Retinal fundus photograph; 2352x1568; FOV: 45 degrees:
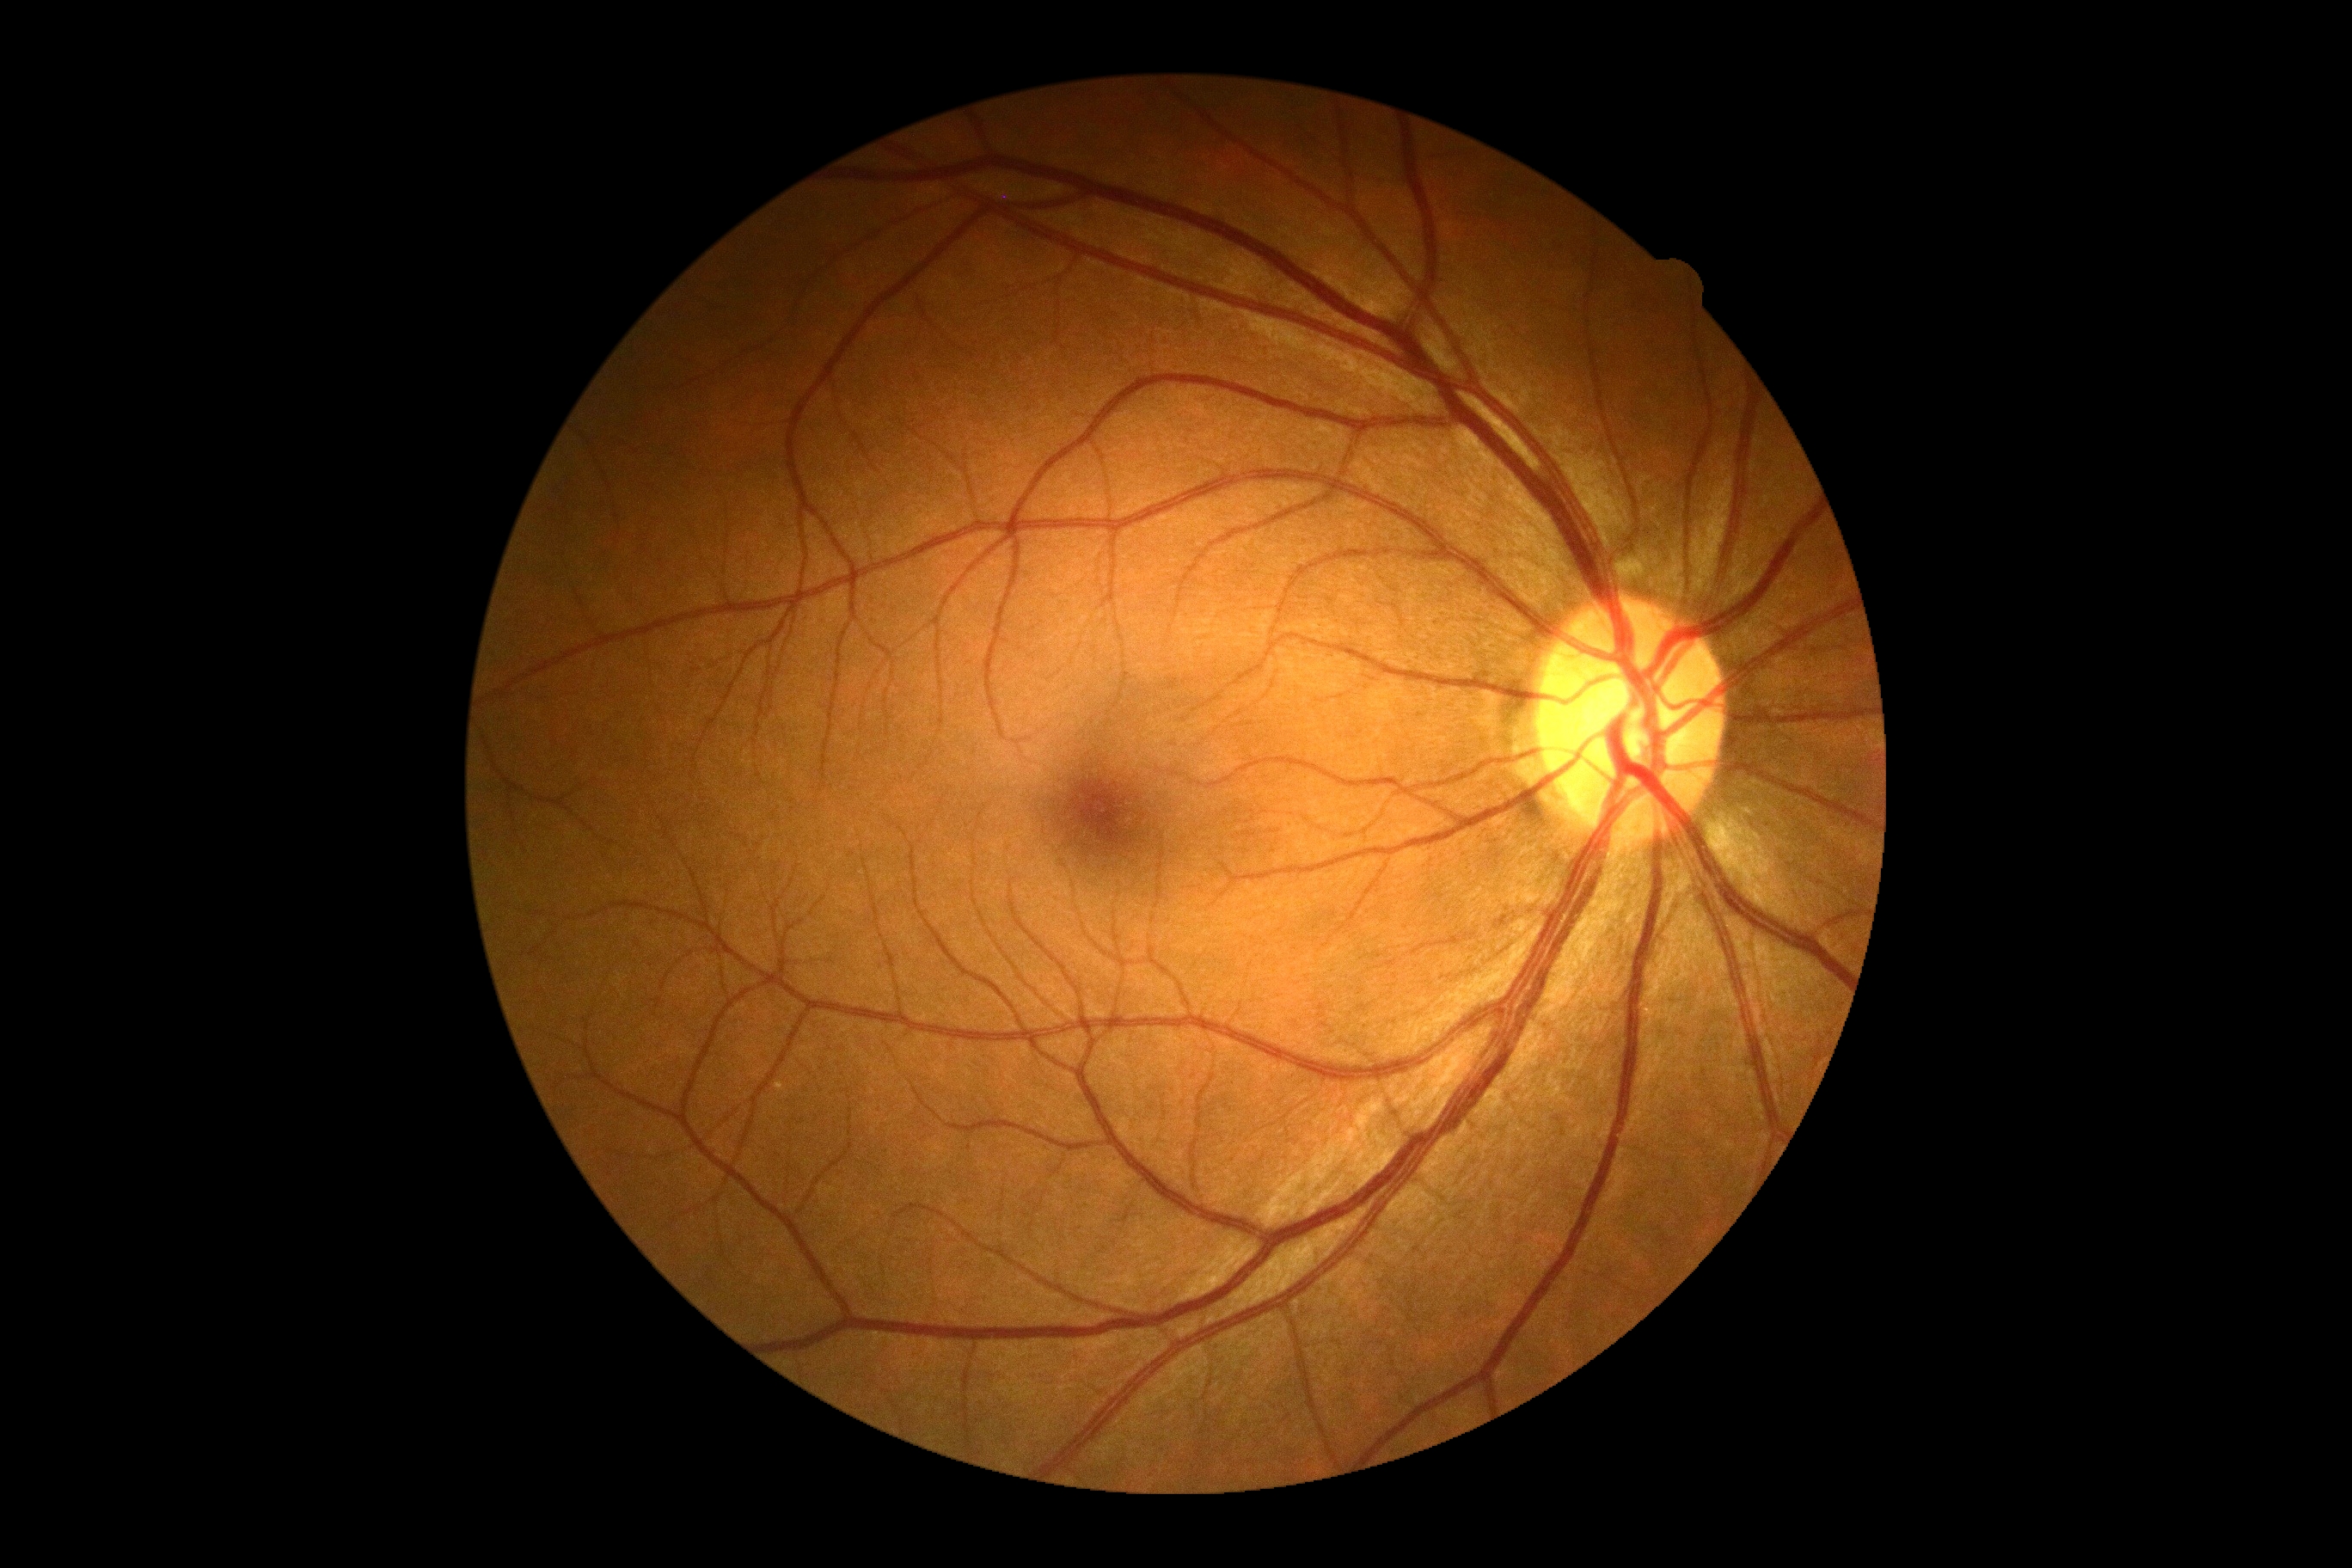

No DR findings. Diabetic retinopathy grade is 0/4.